Retinal fundus photograph. Captured on a Nidek AFC-330 fundus camera: 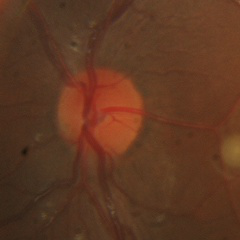

There is evidence of no glaucomatous changes.